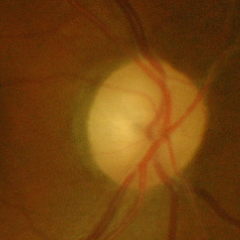
Glaucoma status = advanced glaucoma. Defined as near-total cupping of the optic nerve head, with or without severe visual field loss within the central 10 degrees of fixation.